848 by 848 pixels; 45° FOV:
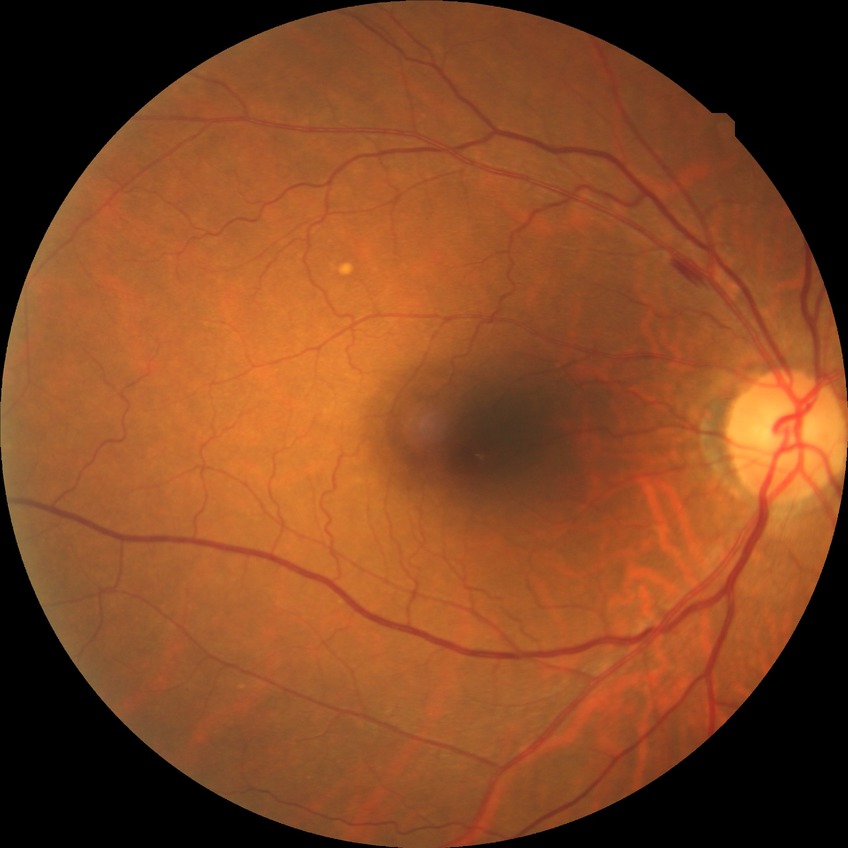 Modified Davis grade is NDR. No DR findings.